Infant wide-field retinal image · 1440 by 1080 pixels
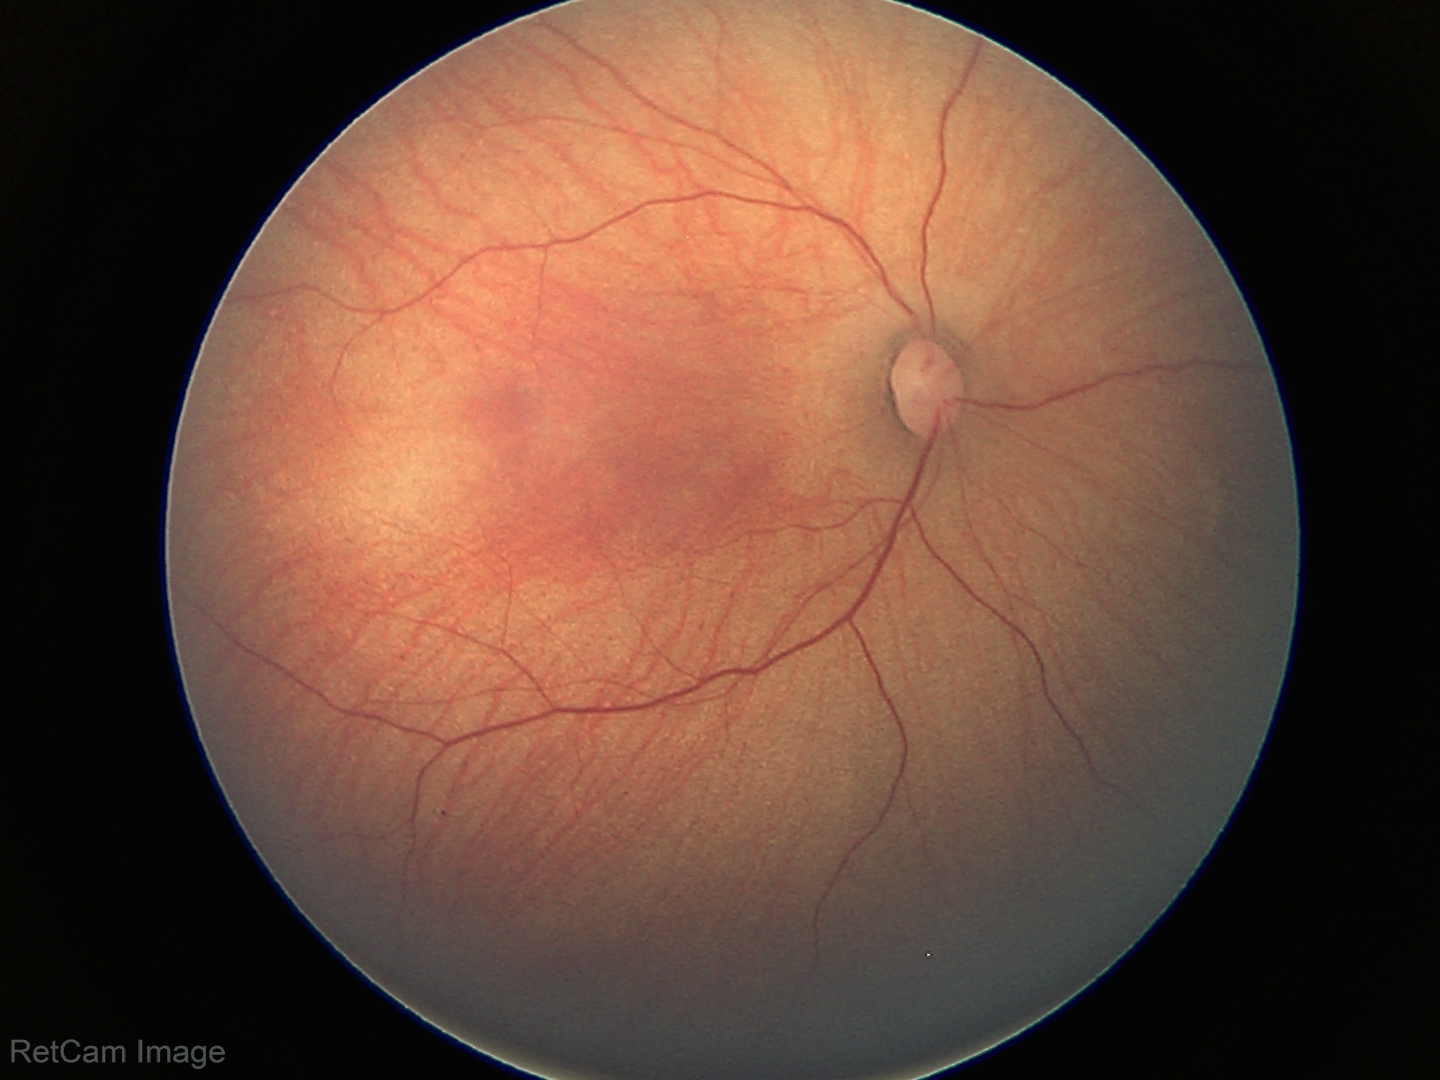

Screening examination with no abnormal retinal findings.